Color fundus image.
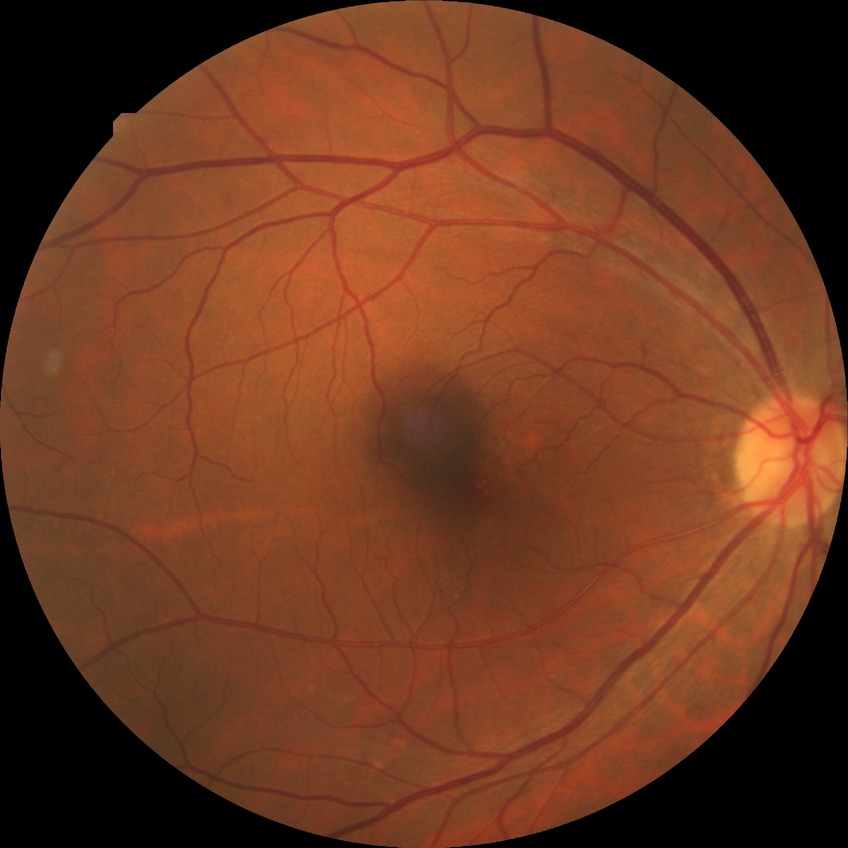
Modified Davis grade is NDR.